640x480. Wide-field fundus photograph of an infant. Clarity RetCam 3, 130° FOV — 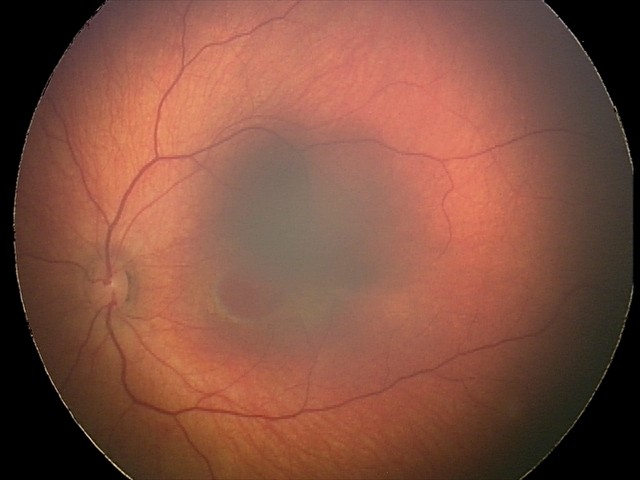 Series diagnosed as retinal hemorrhages.